CFP — 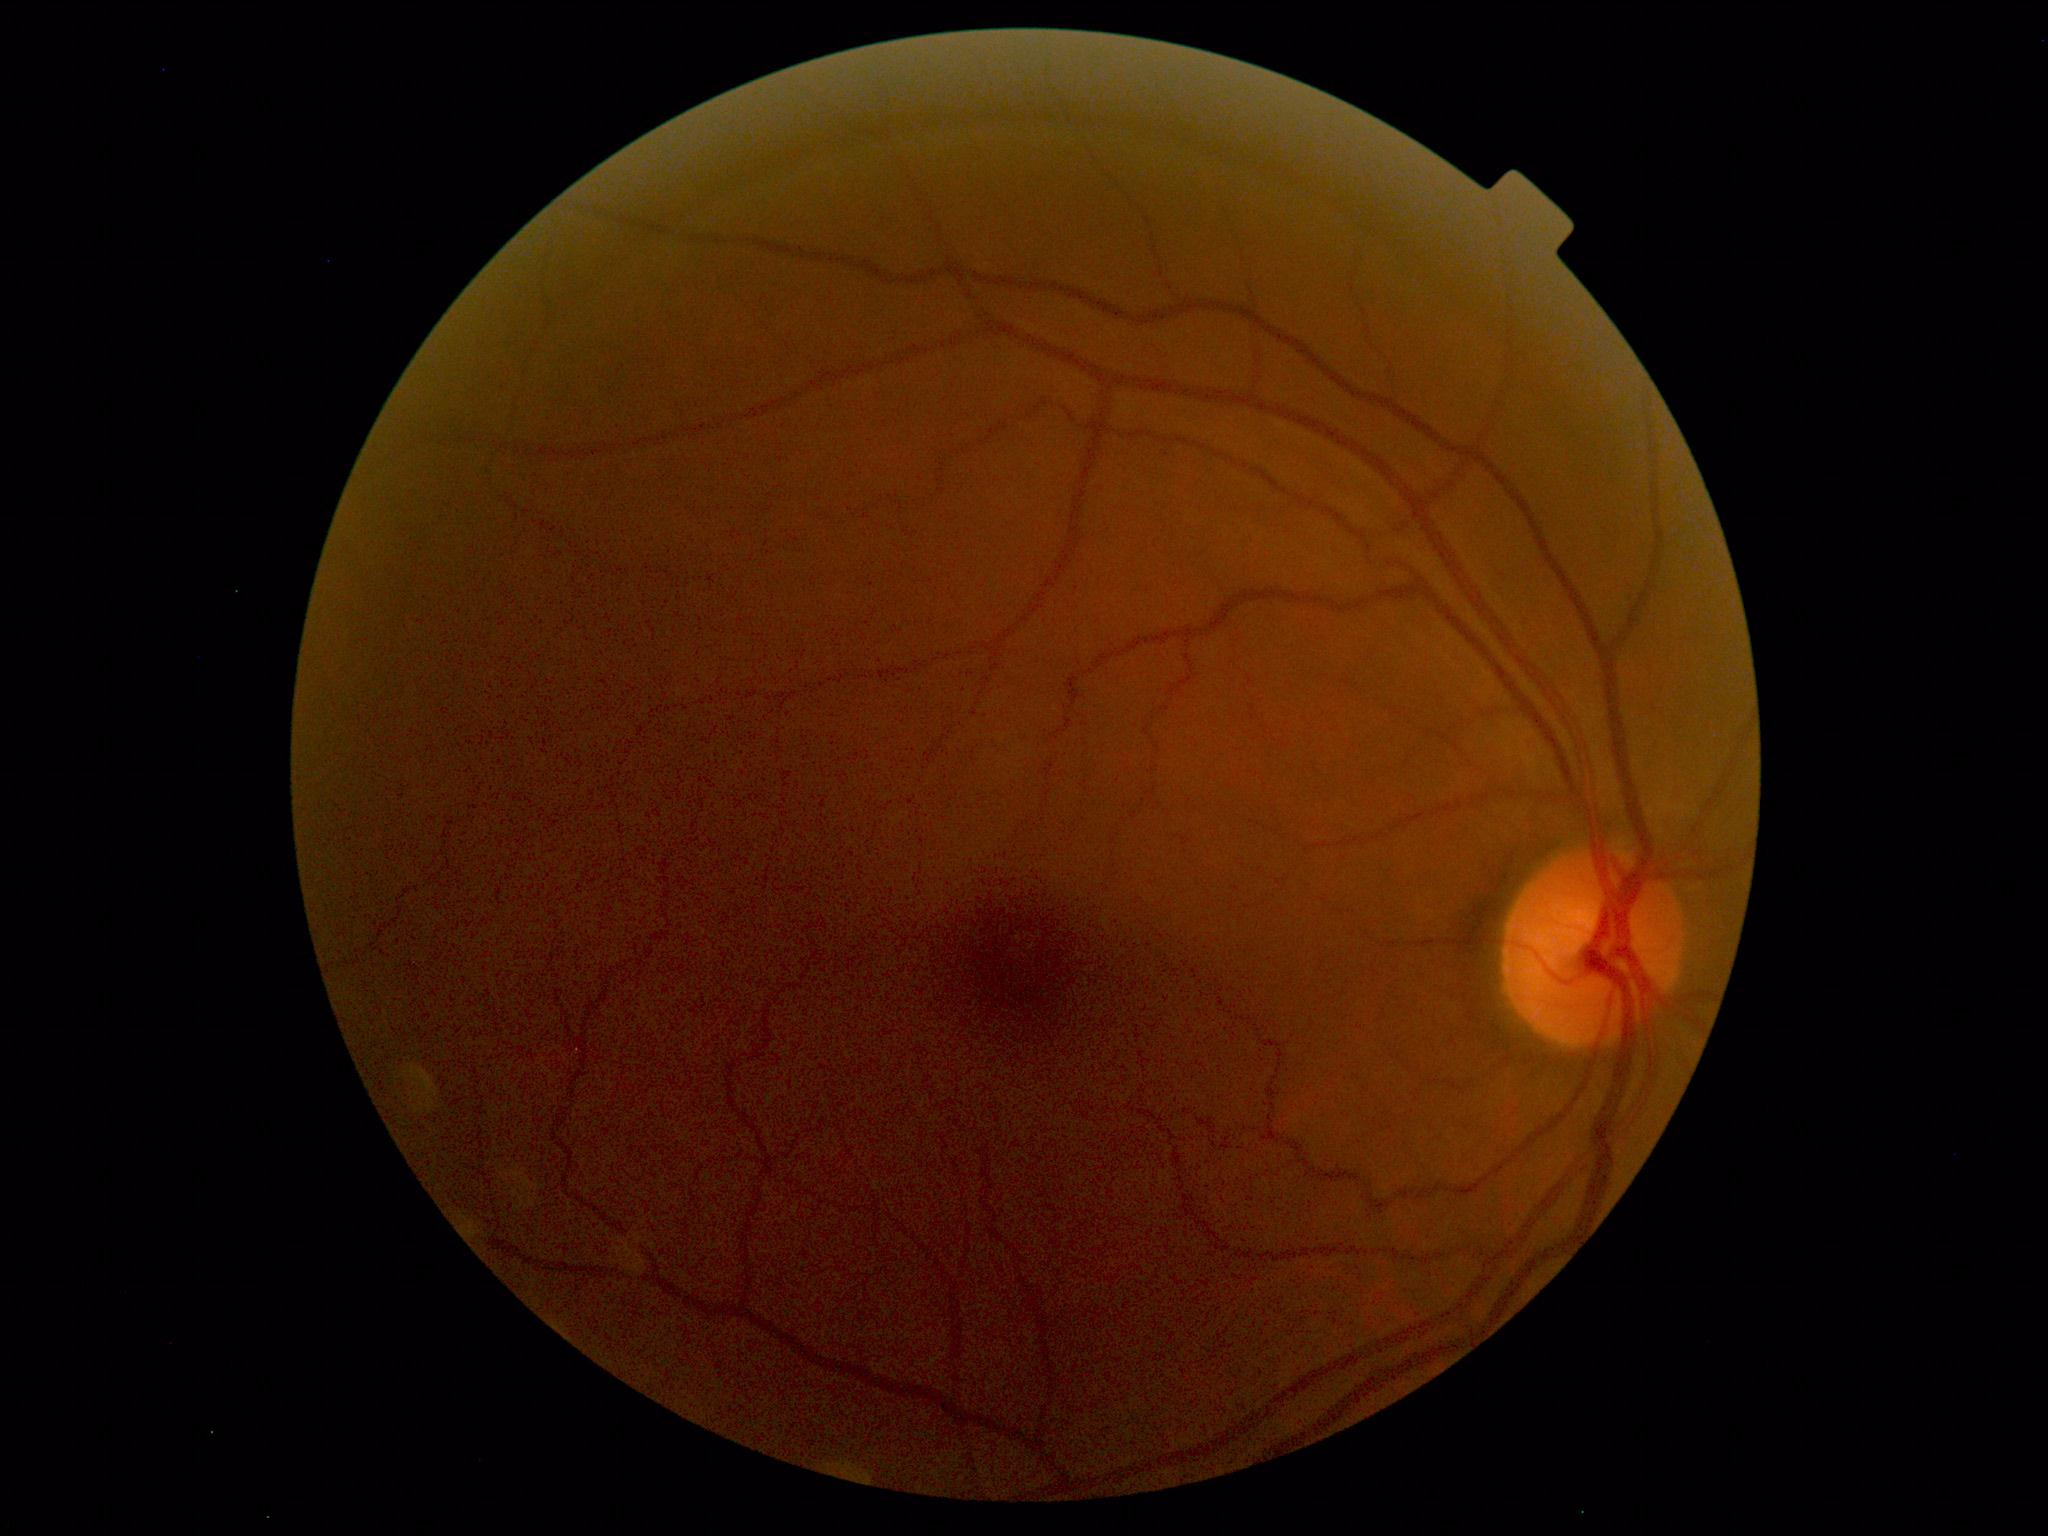
Impression: normal fundus.